2184 x 1690 pixels:
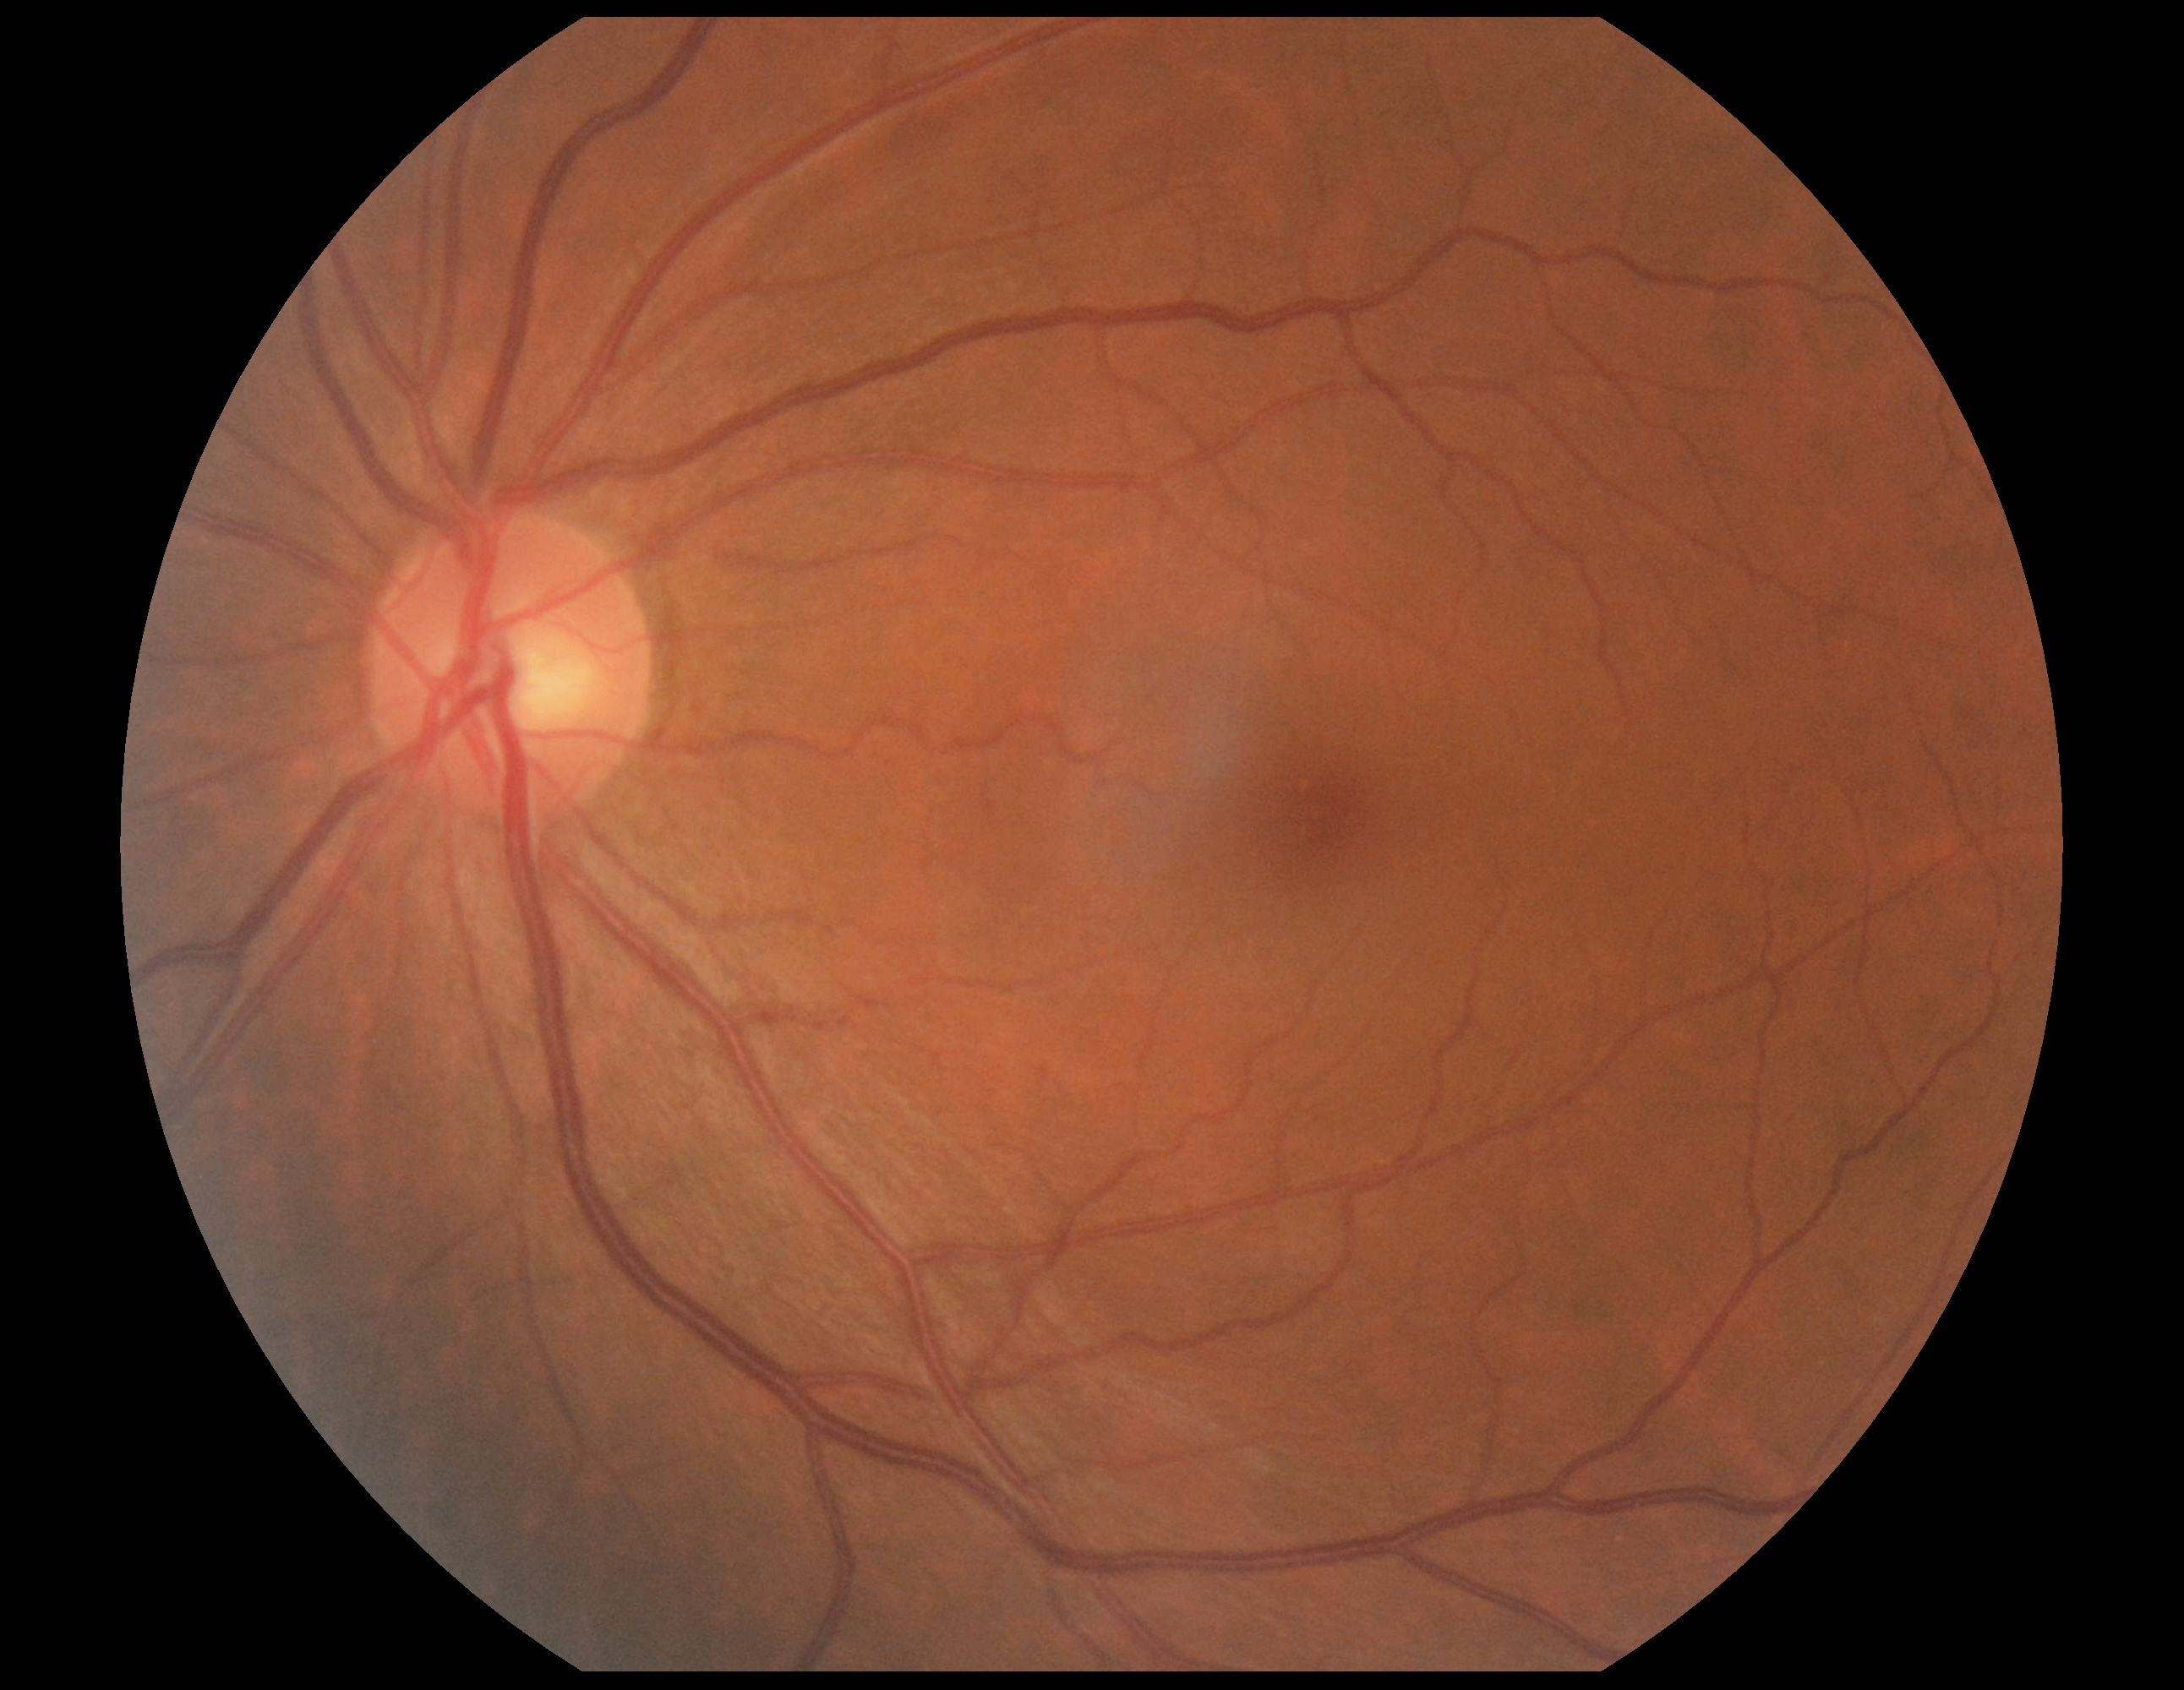
{"dr_impression": "no signs of DR", "dr_grade": "0"}